Centered on the macula
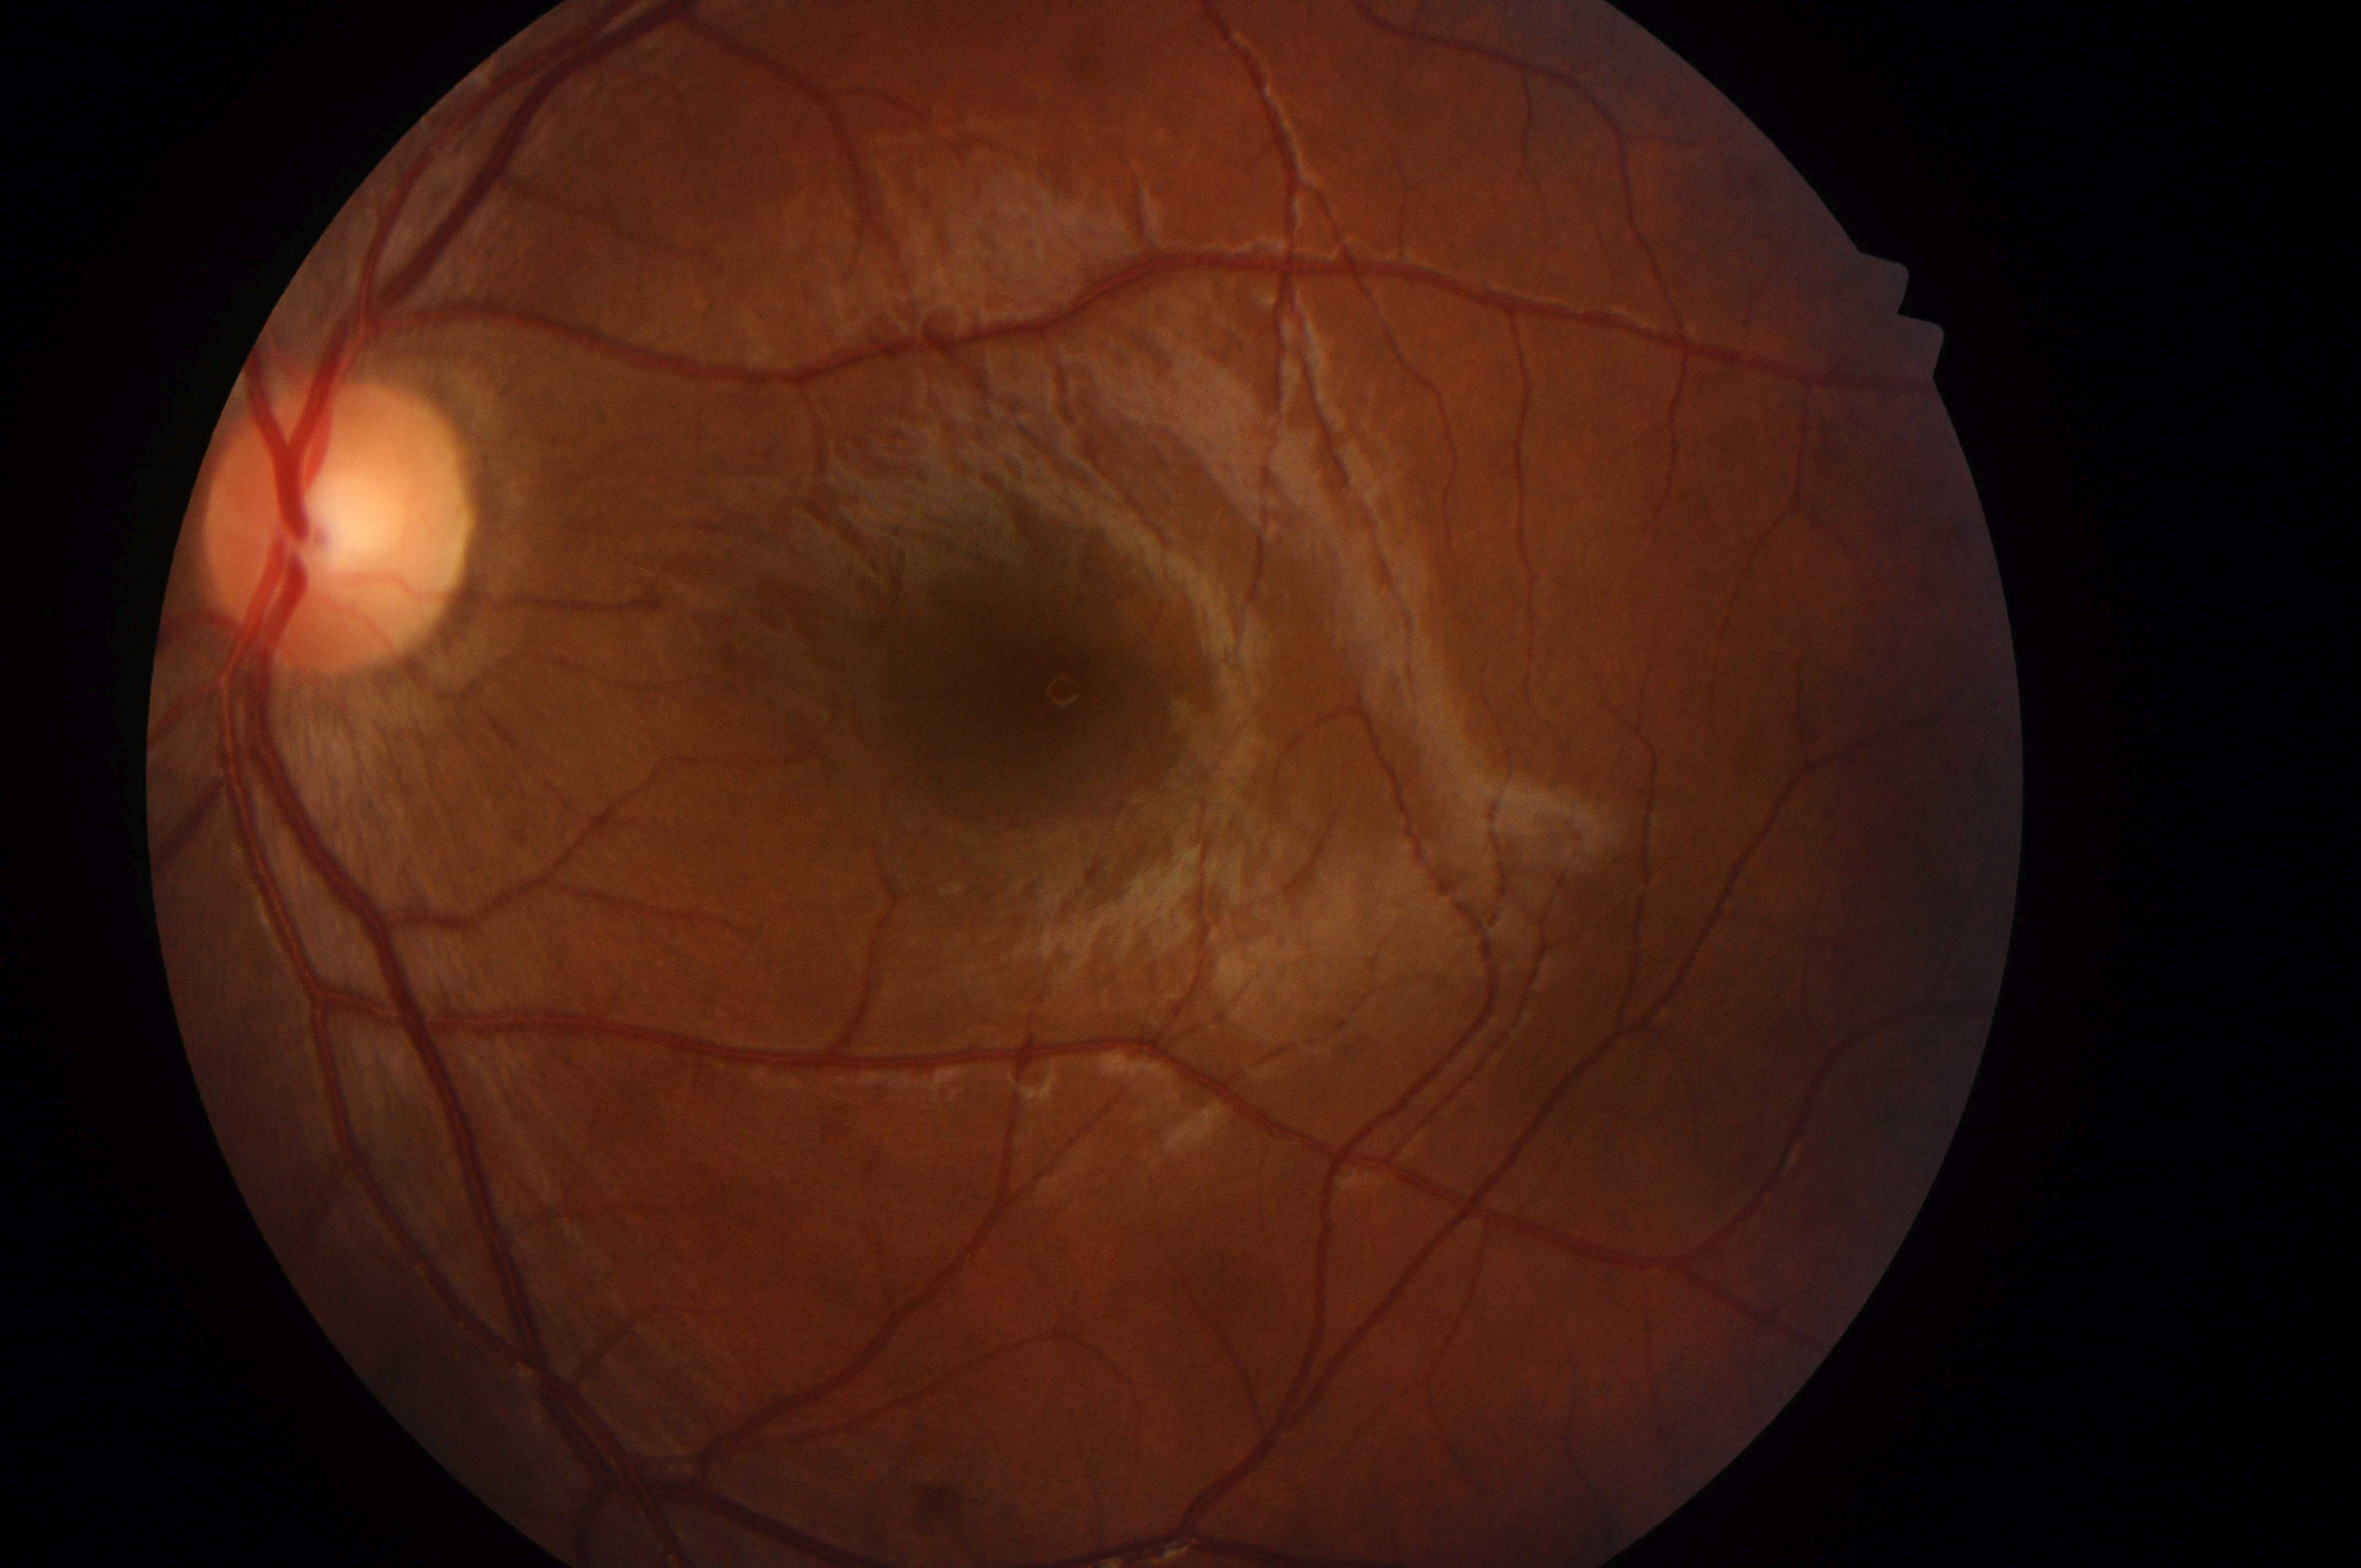
| feature | annotation |
|---|---|
| laterality | left eye |
| retinopathy | grade 0 |
| fovea | x=1035, y=696 |
| risk of macular edema | 0/2 |
| optic disc center | x=330, y=533 |